Image size 848x848, FOV: 45 degrees.
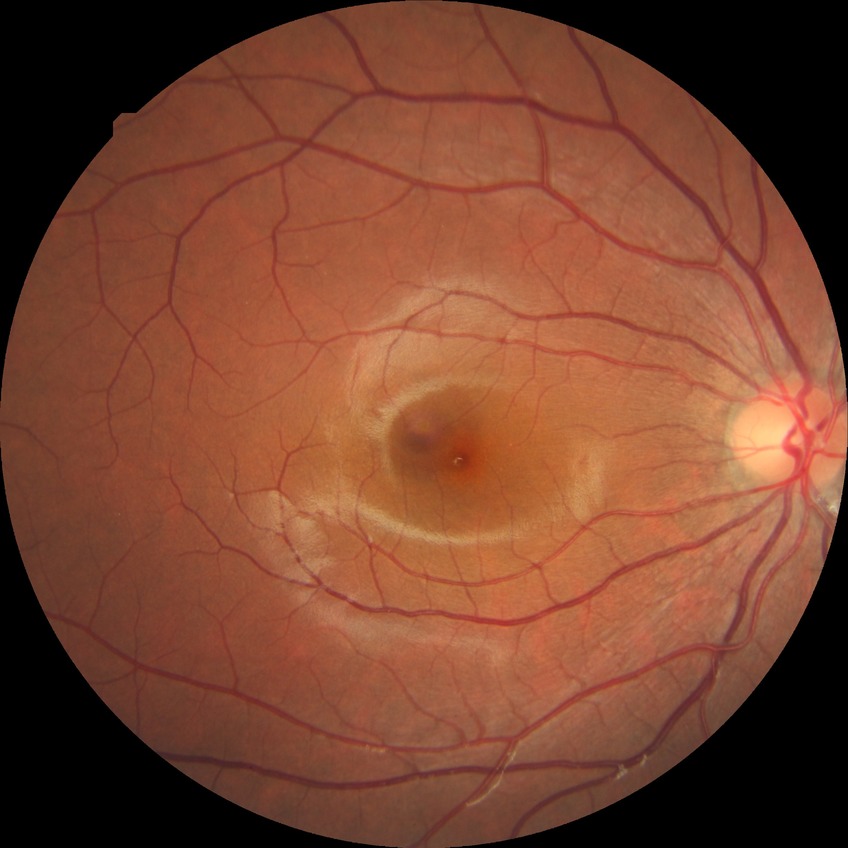 DR is NDR.